Retinal fundus photograph; 45° field of view — 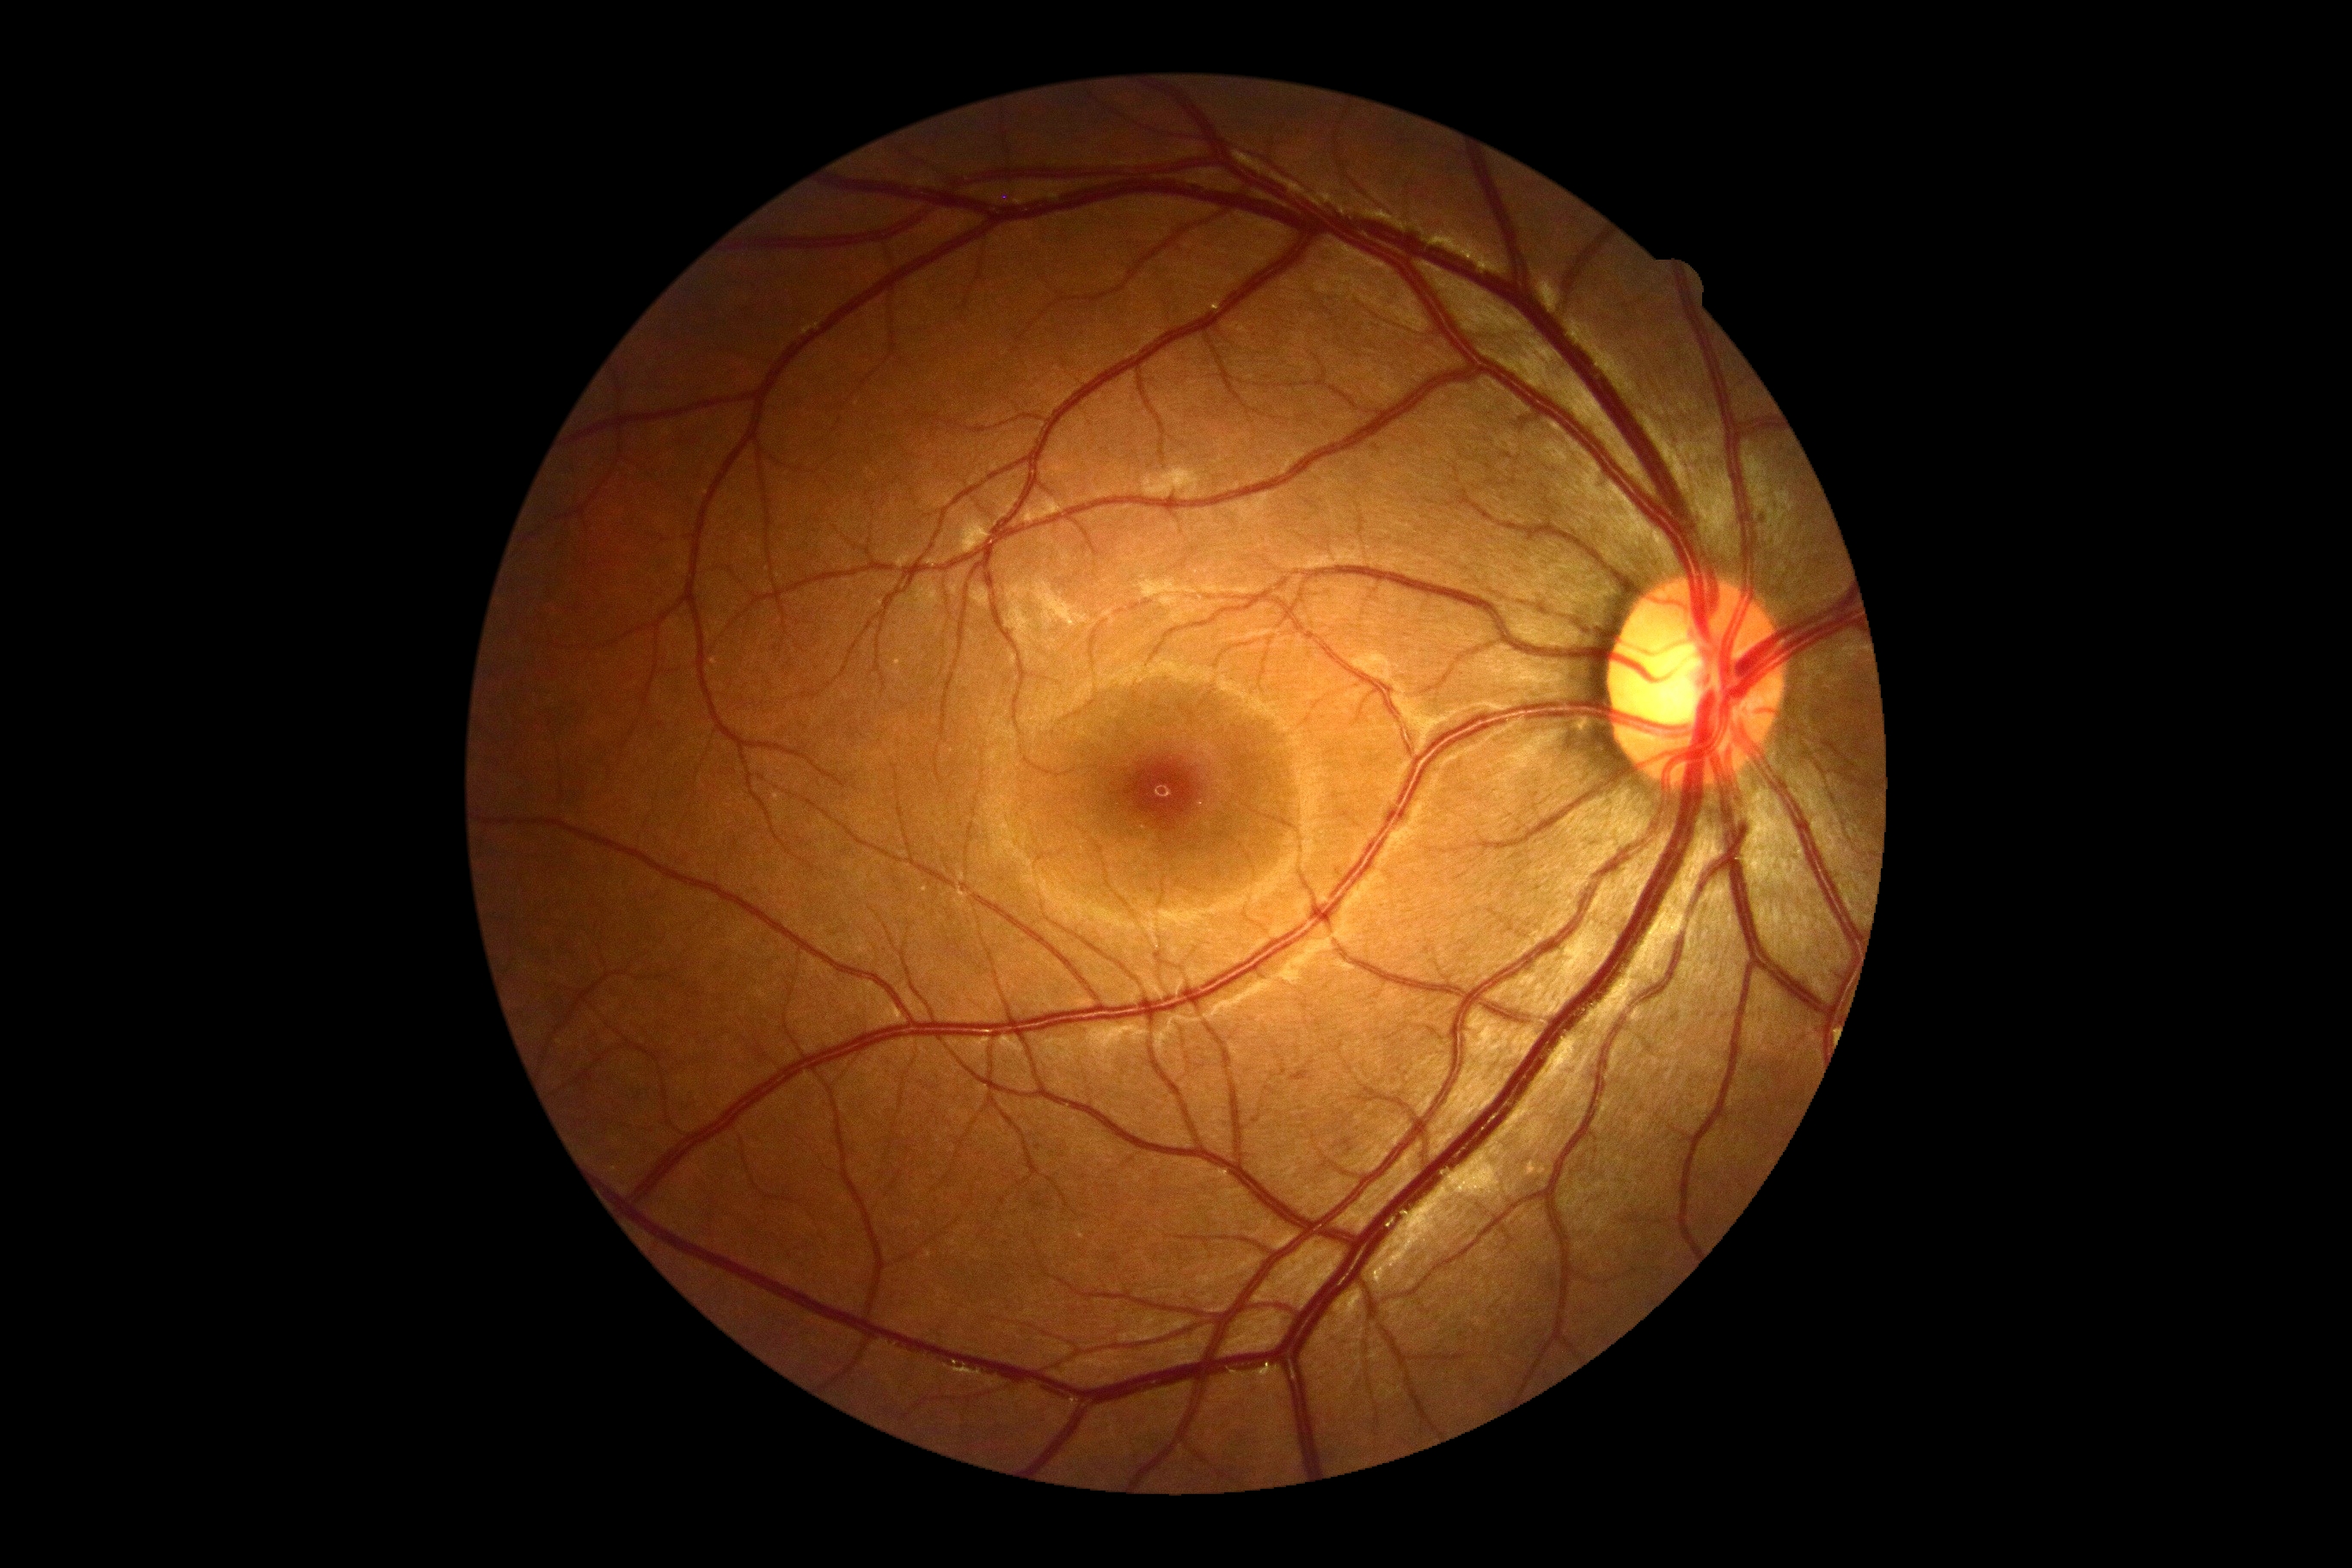 Retinopathy grade: 0.